Captured without pupil dilation — 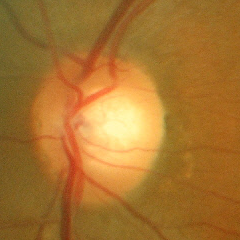
Glaucoma assessment: no signs of glaucoma.